45° FOV, 2352x1568, fundus photo:
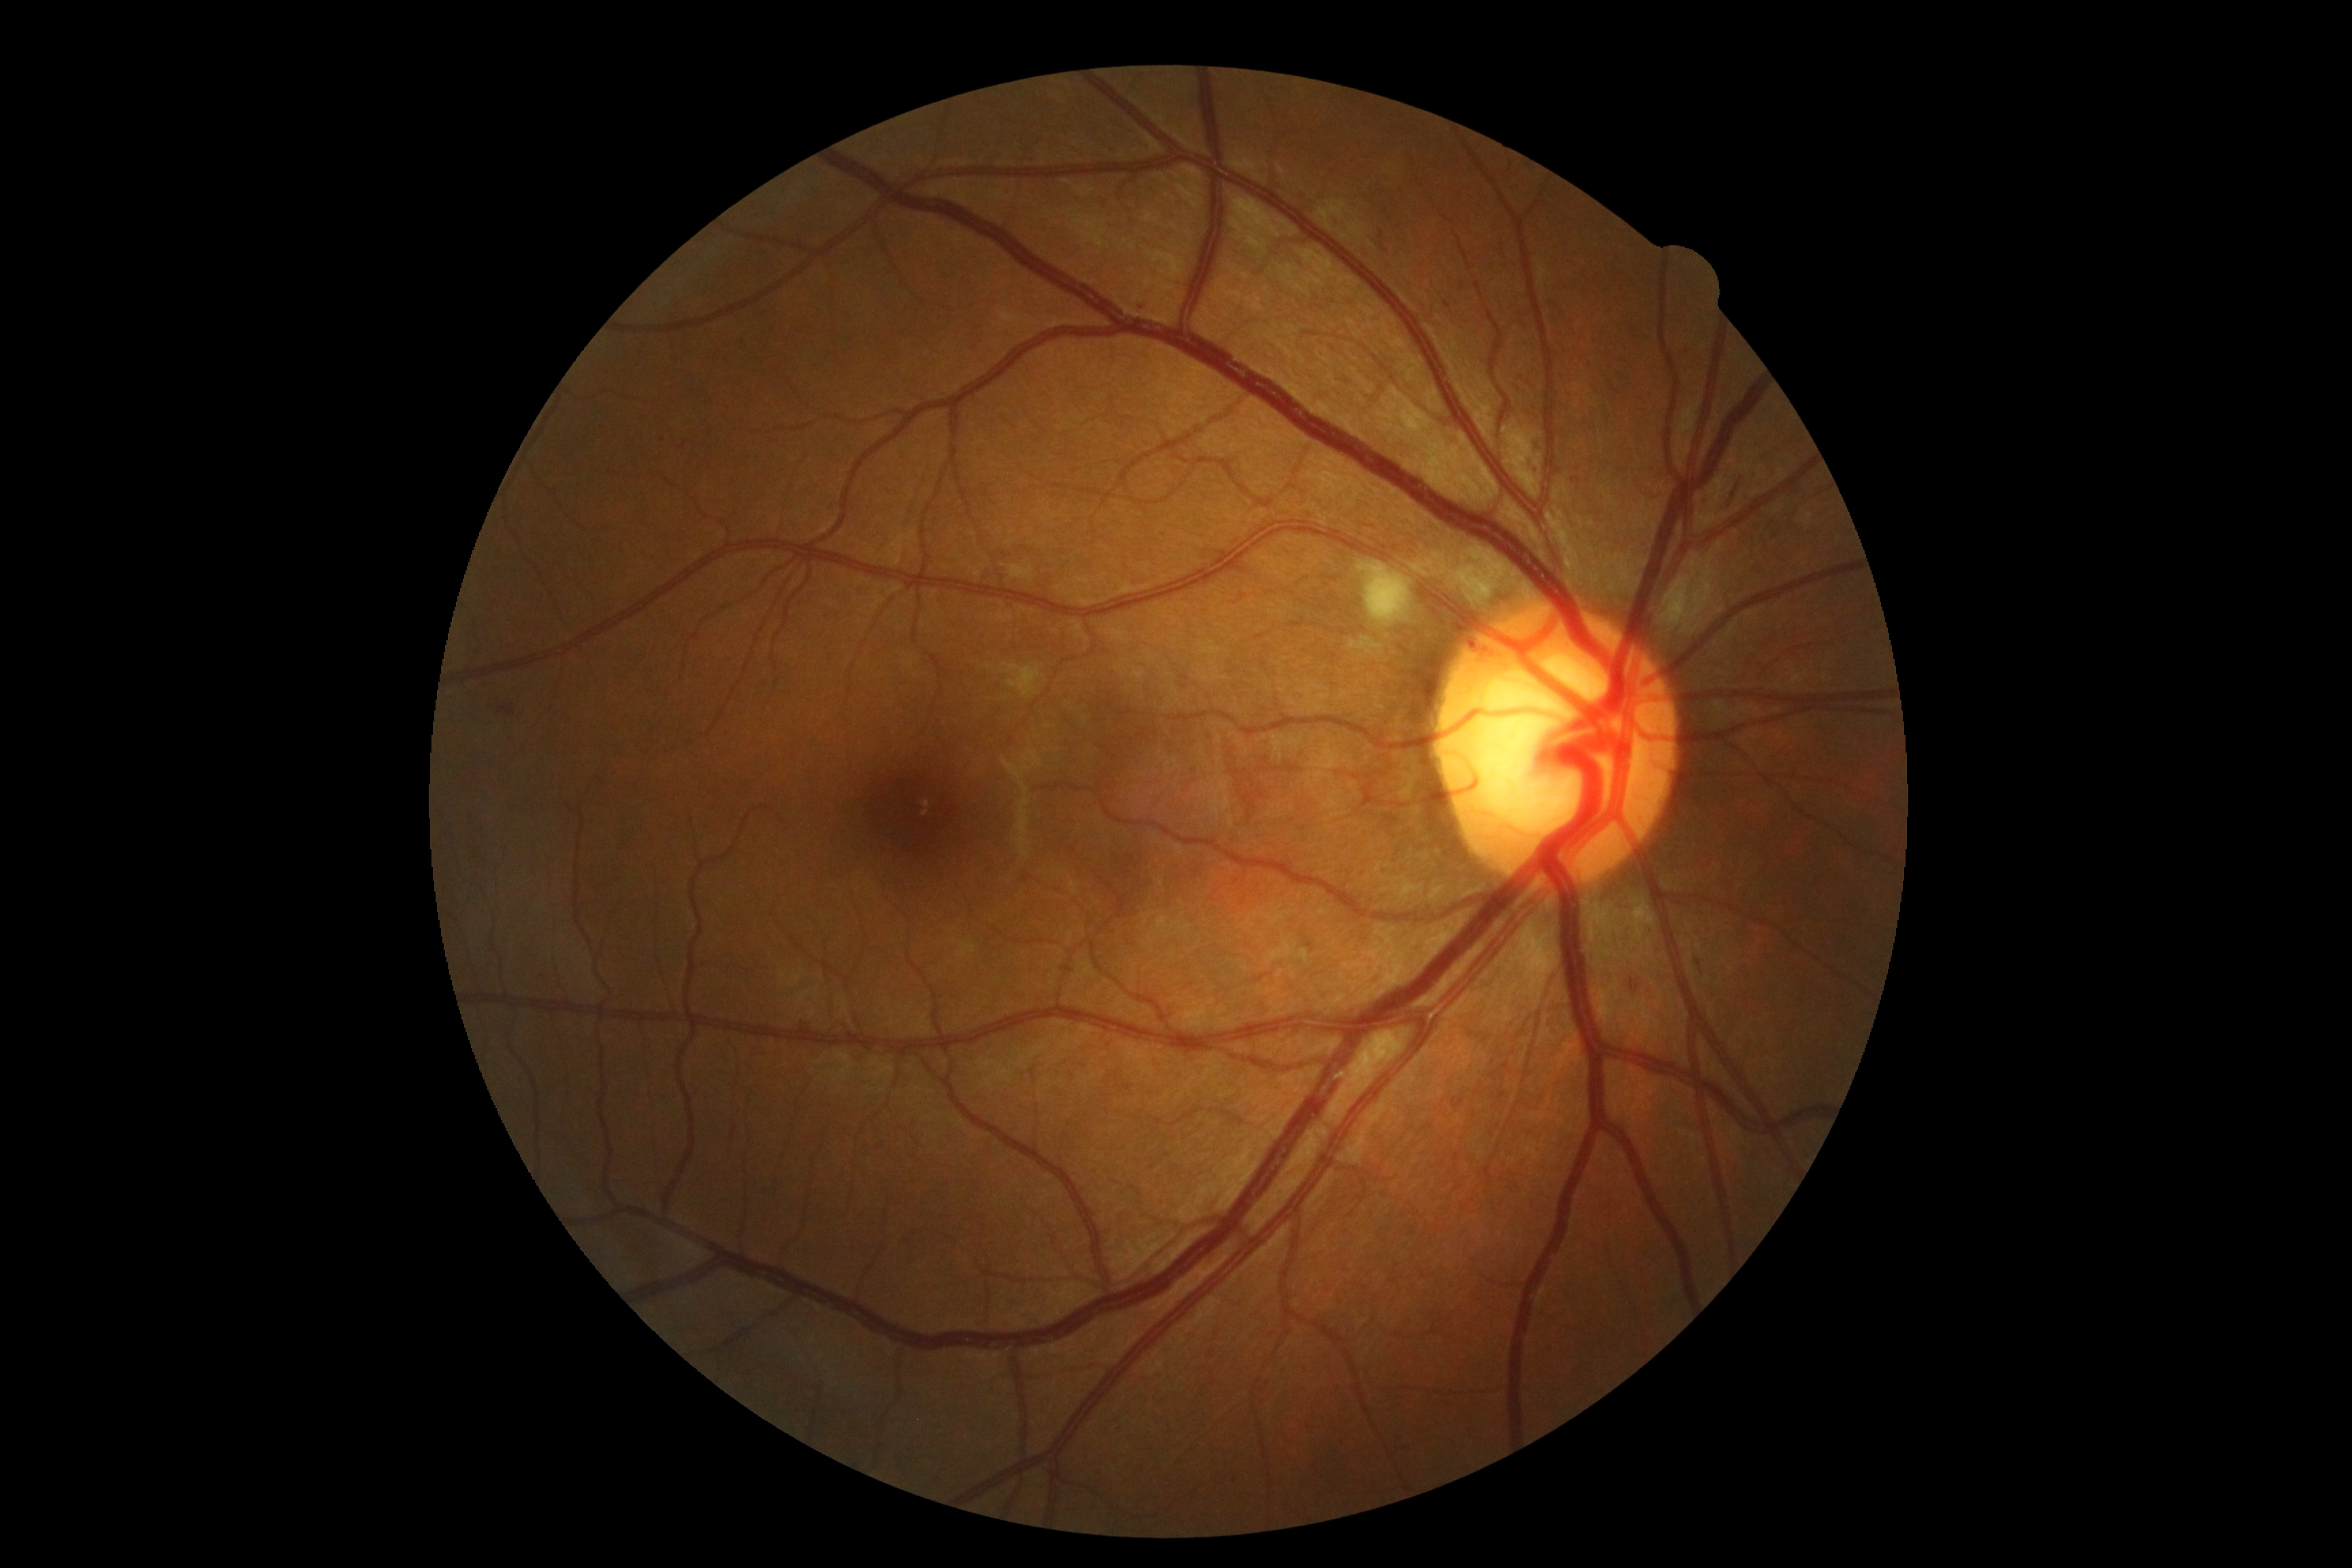
DR severity is moderate NPDR (grade 2).